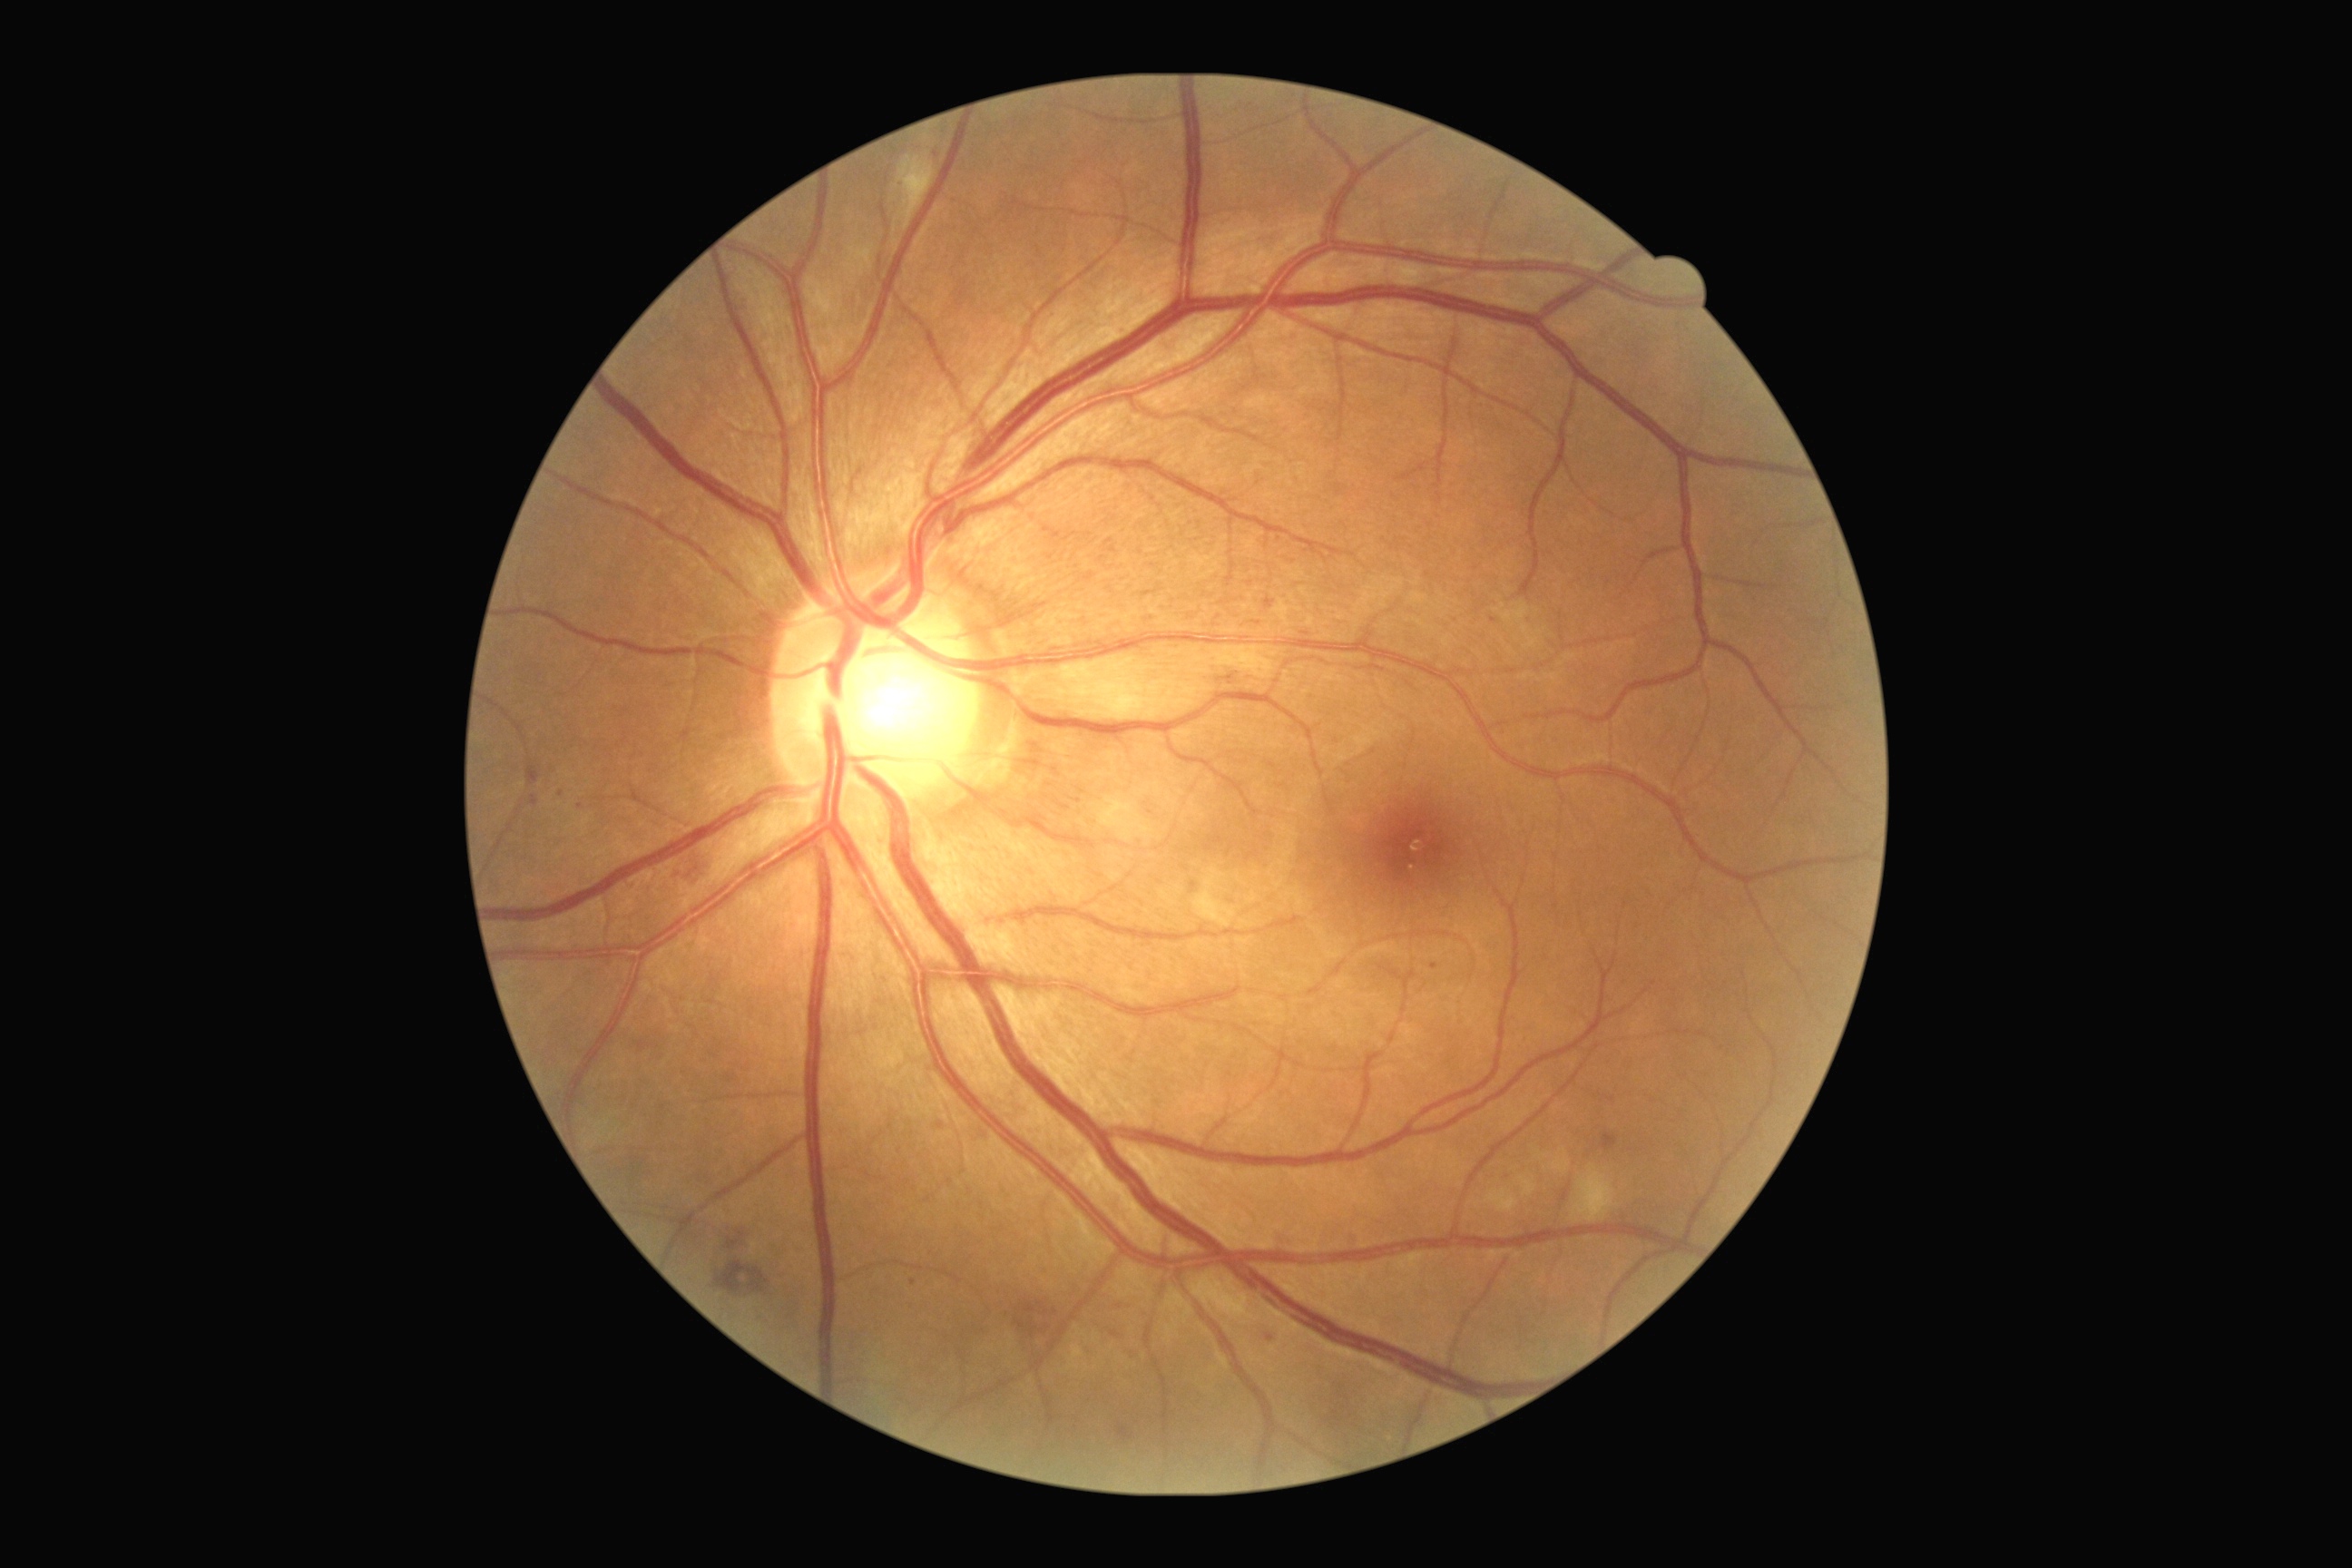
Annotations:
- DR stage: grade 2